Modified Davis classification, CFP, 848x848px, 45 degree fundus photograph.
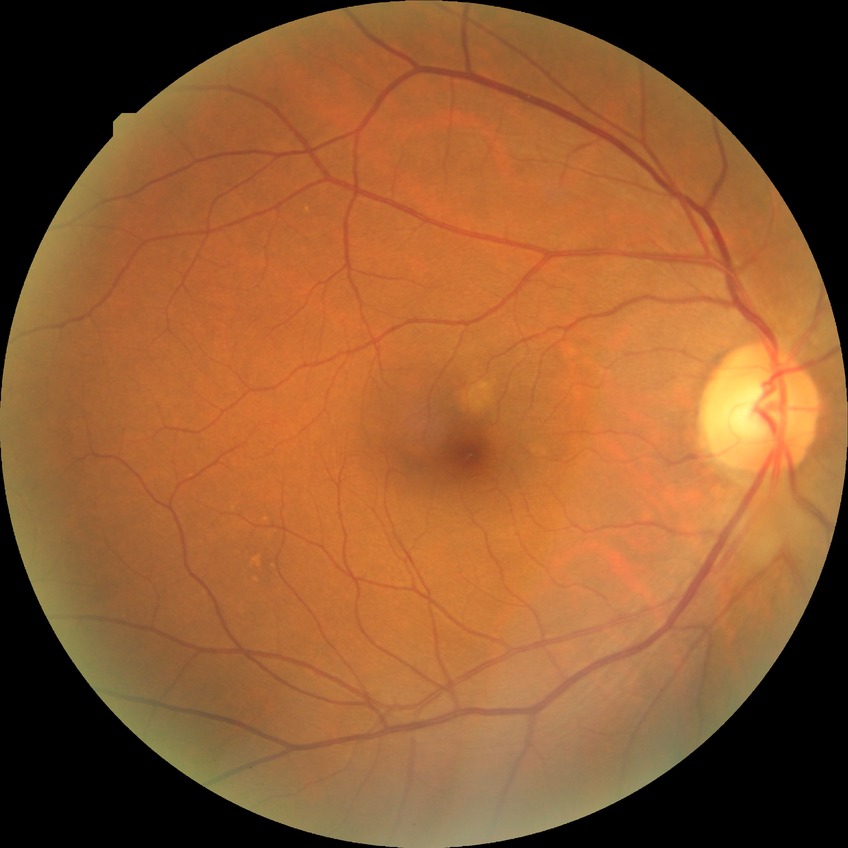 Diabetic retinopathy grade: no diabetic retinopathy.